Captured with pupil dilation. Optic disc photograph: 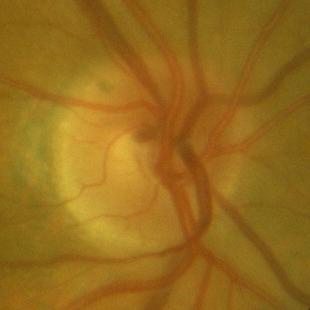
No evidence of glaucoma.